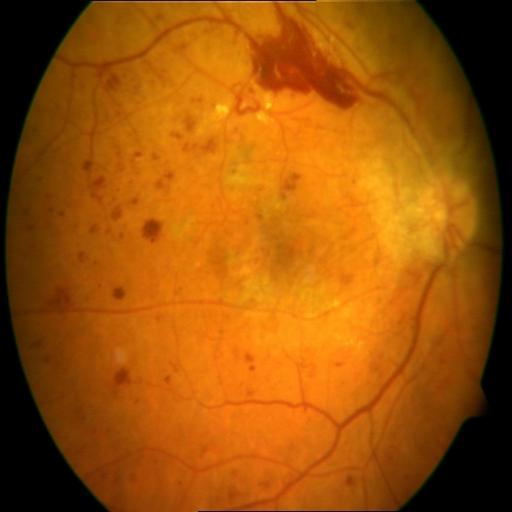

Diagnoses:
- hemorrhagic retinopathy